Remidio Fundus on Phone. 1659x2212px:
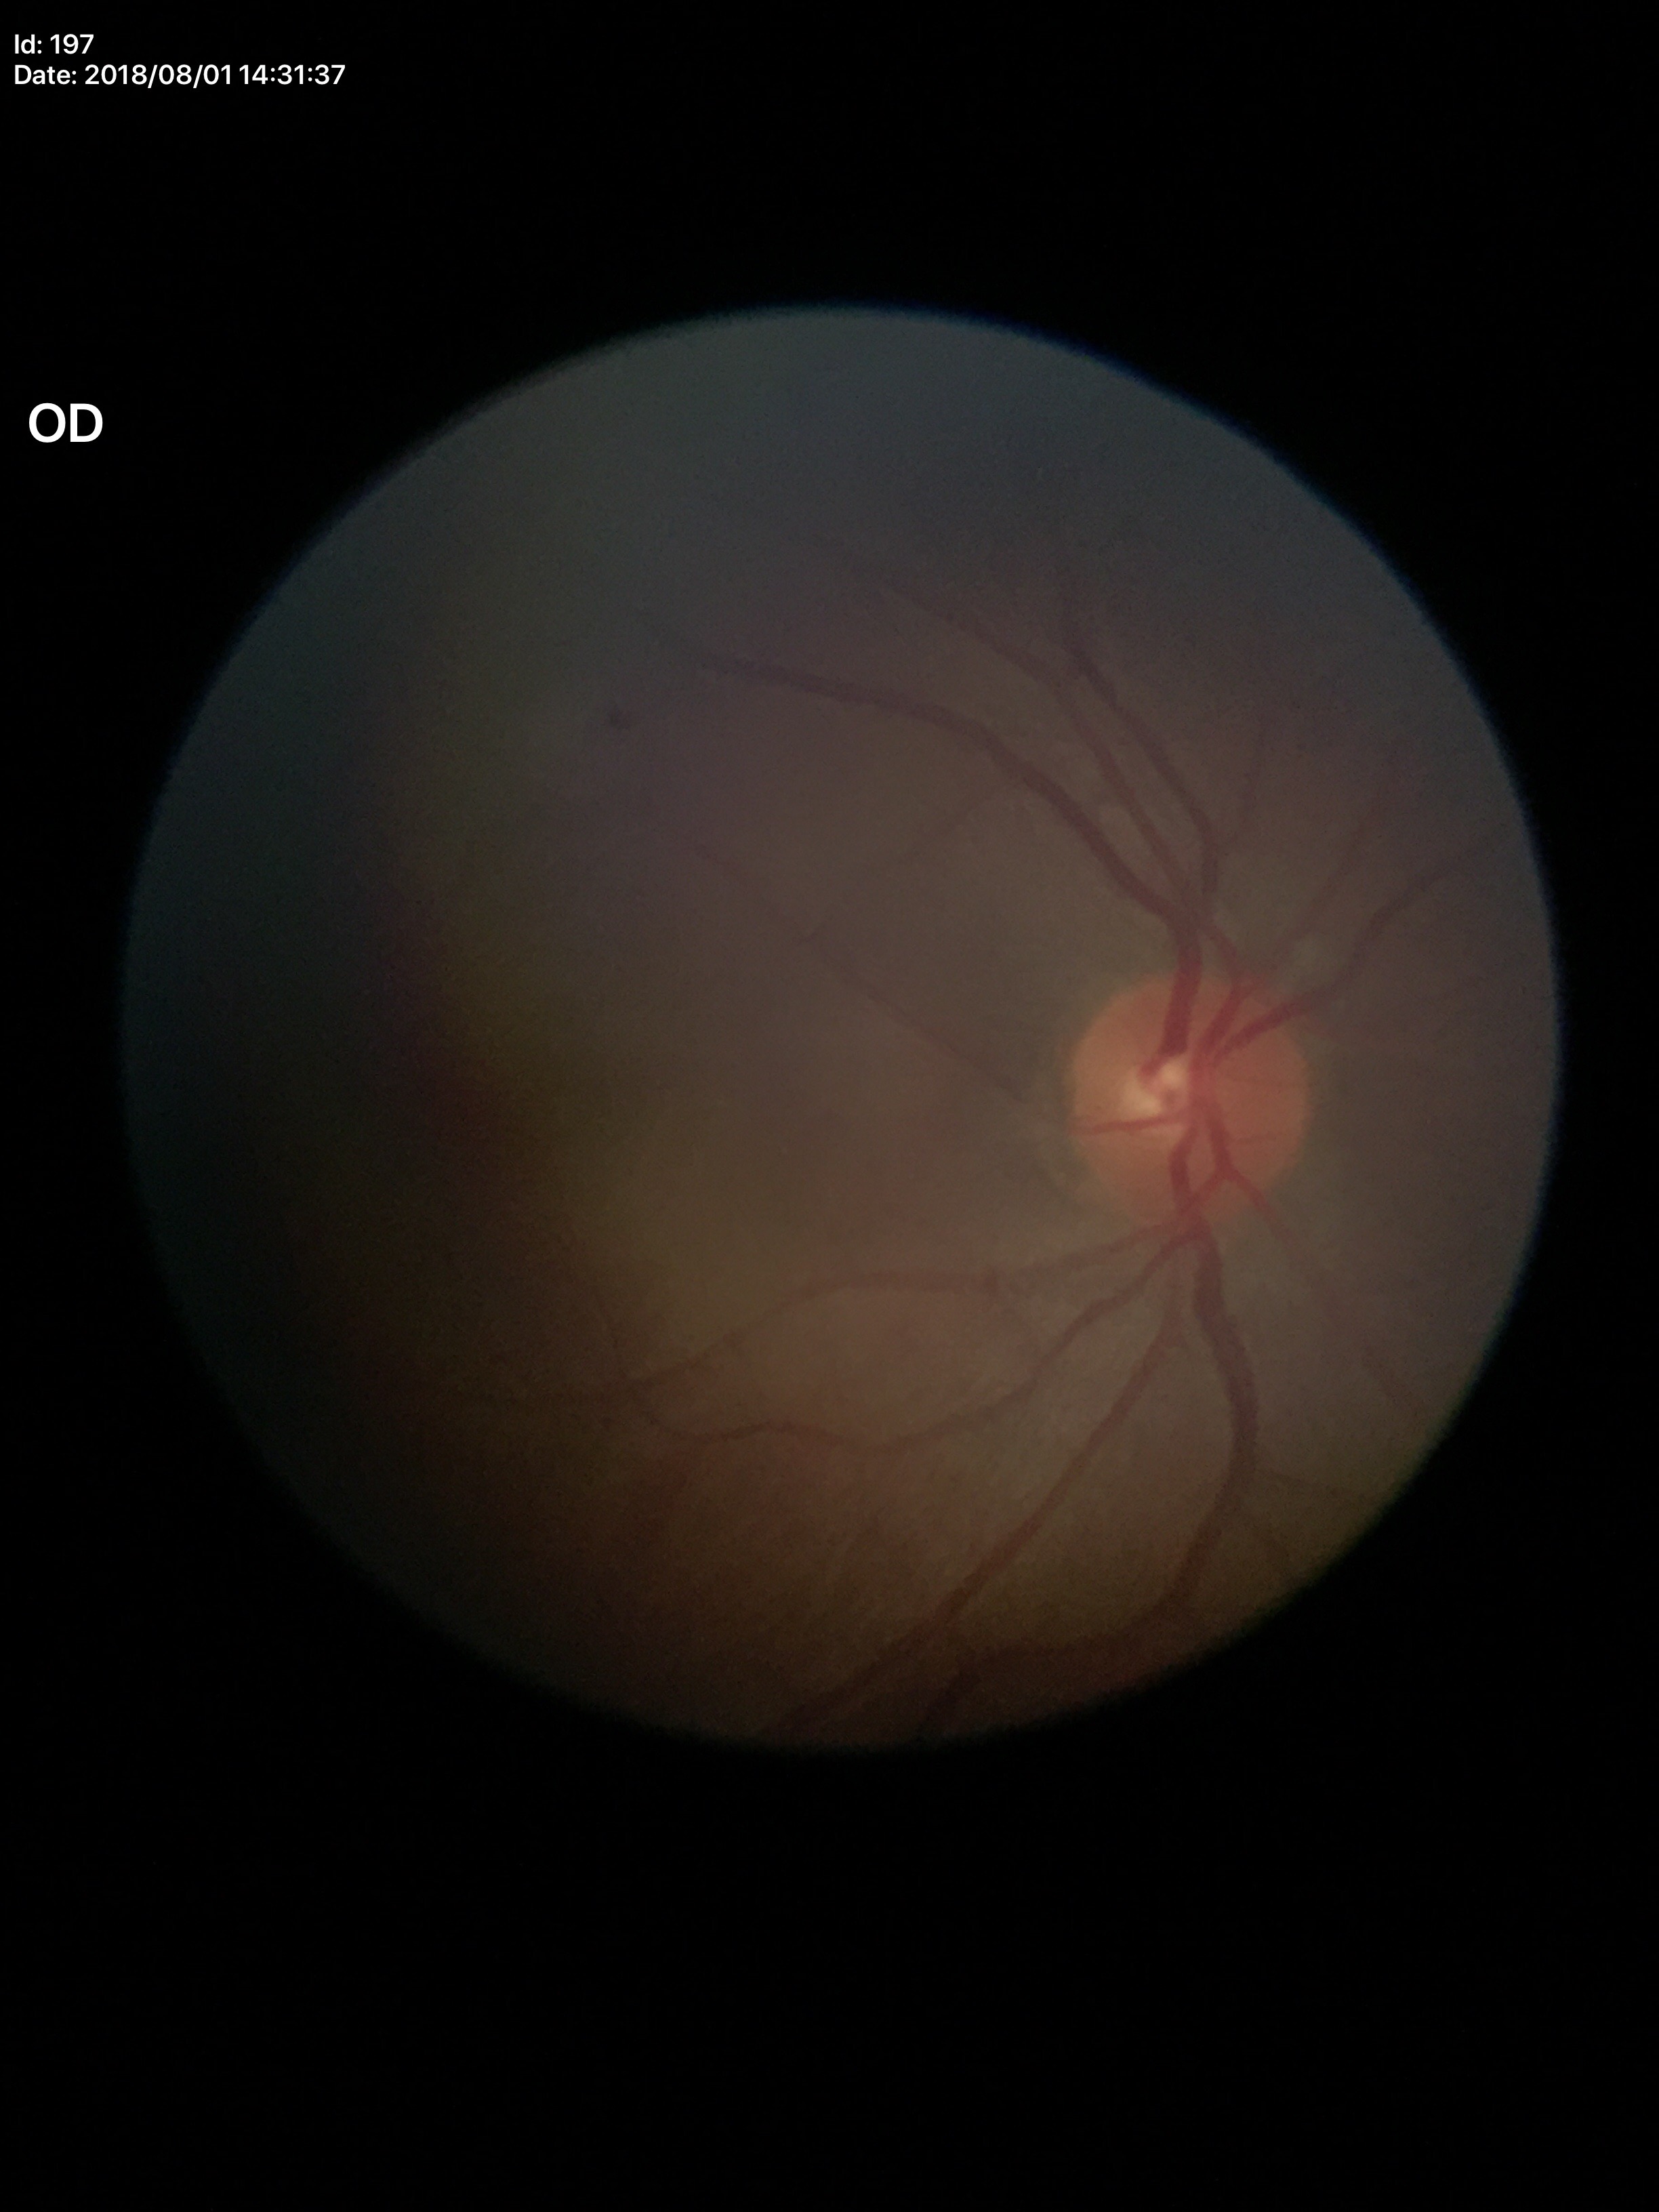
Glaucoma evaluation: no suspicious findings (5/5 ophthalmologists in agreement); vertical C/D ratio (VCDR): 0.44